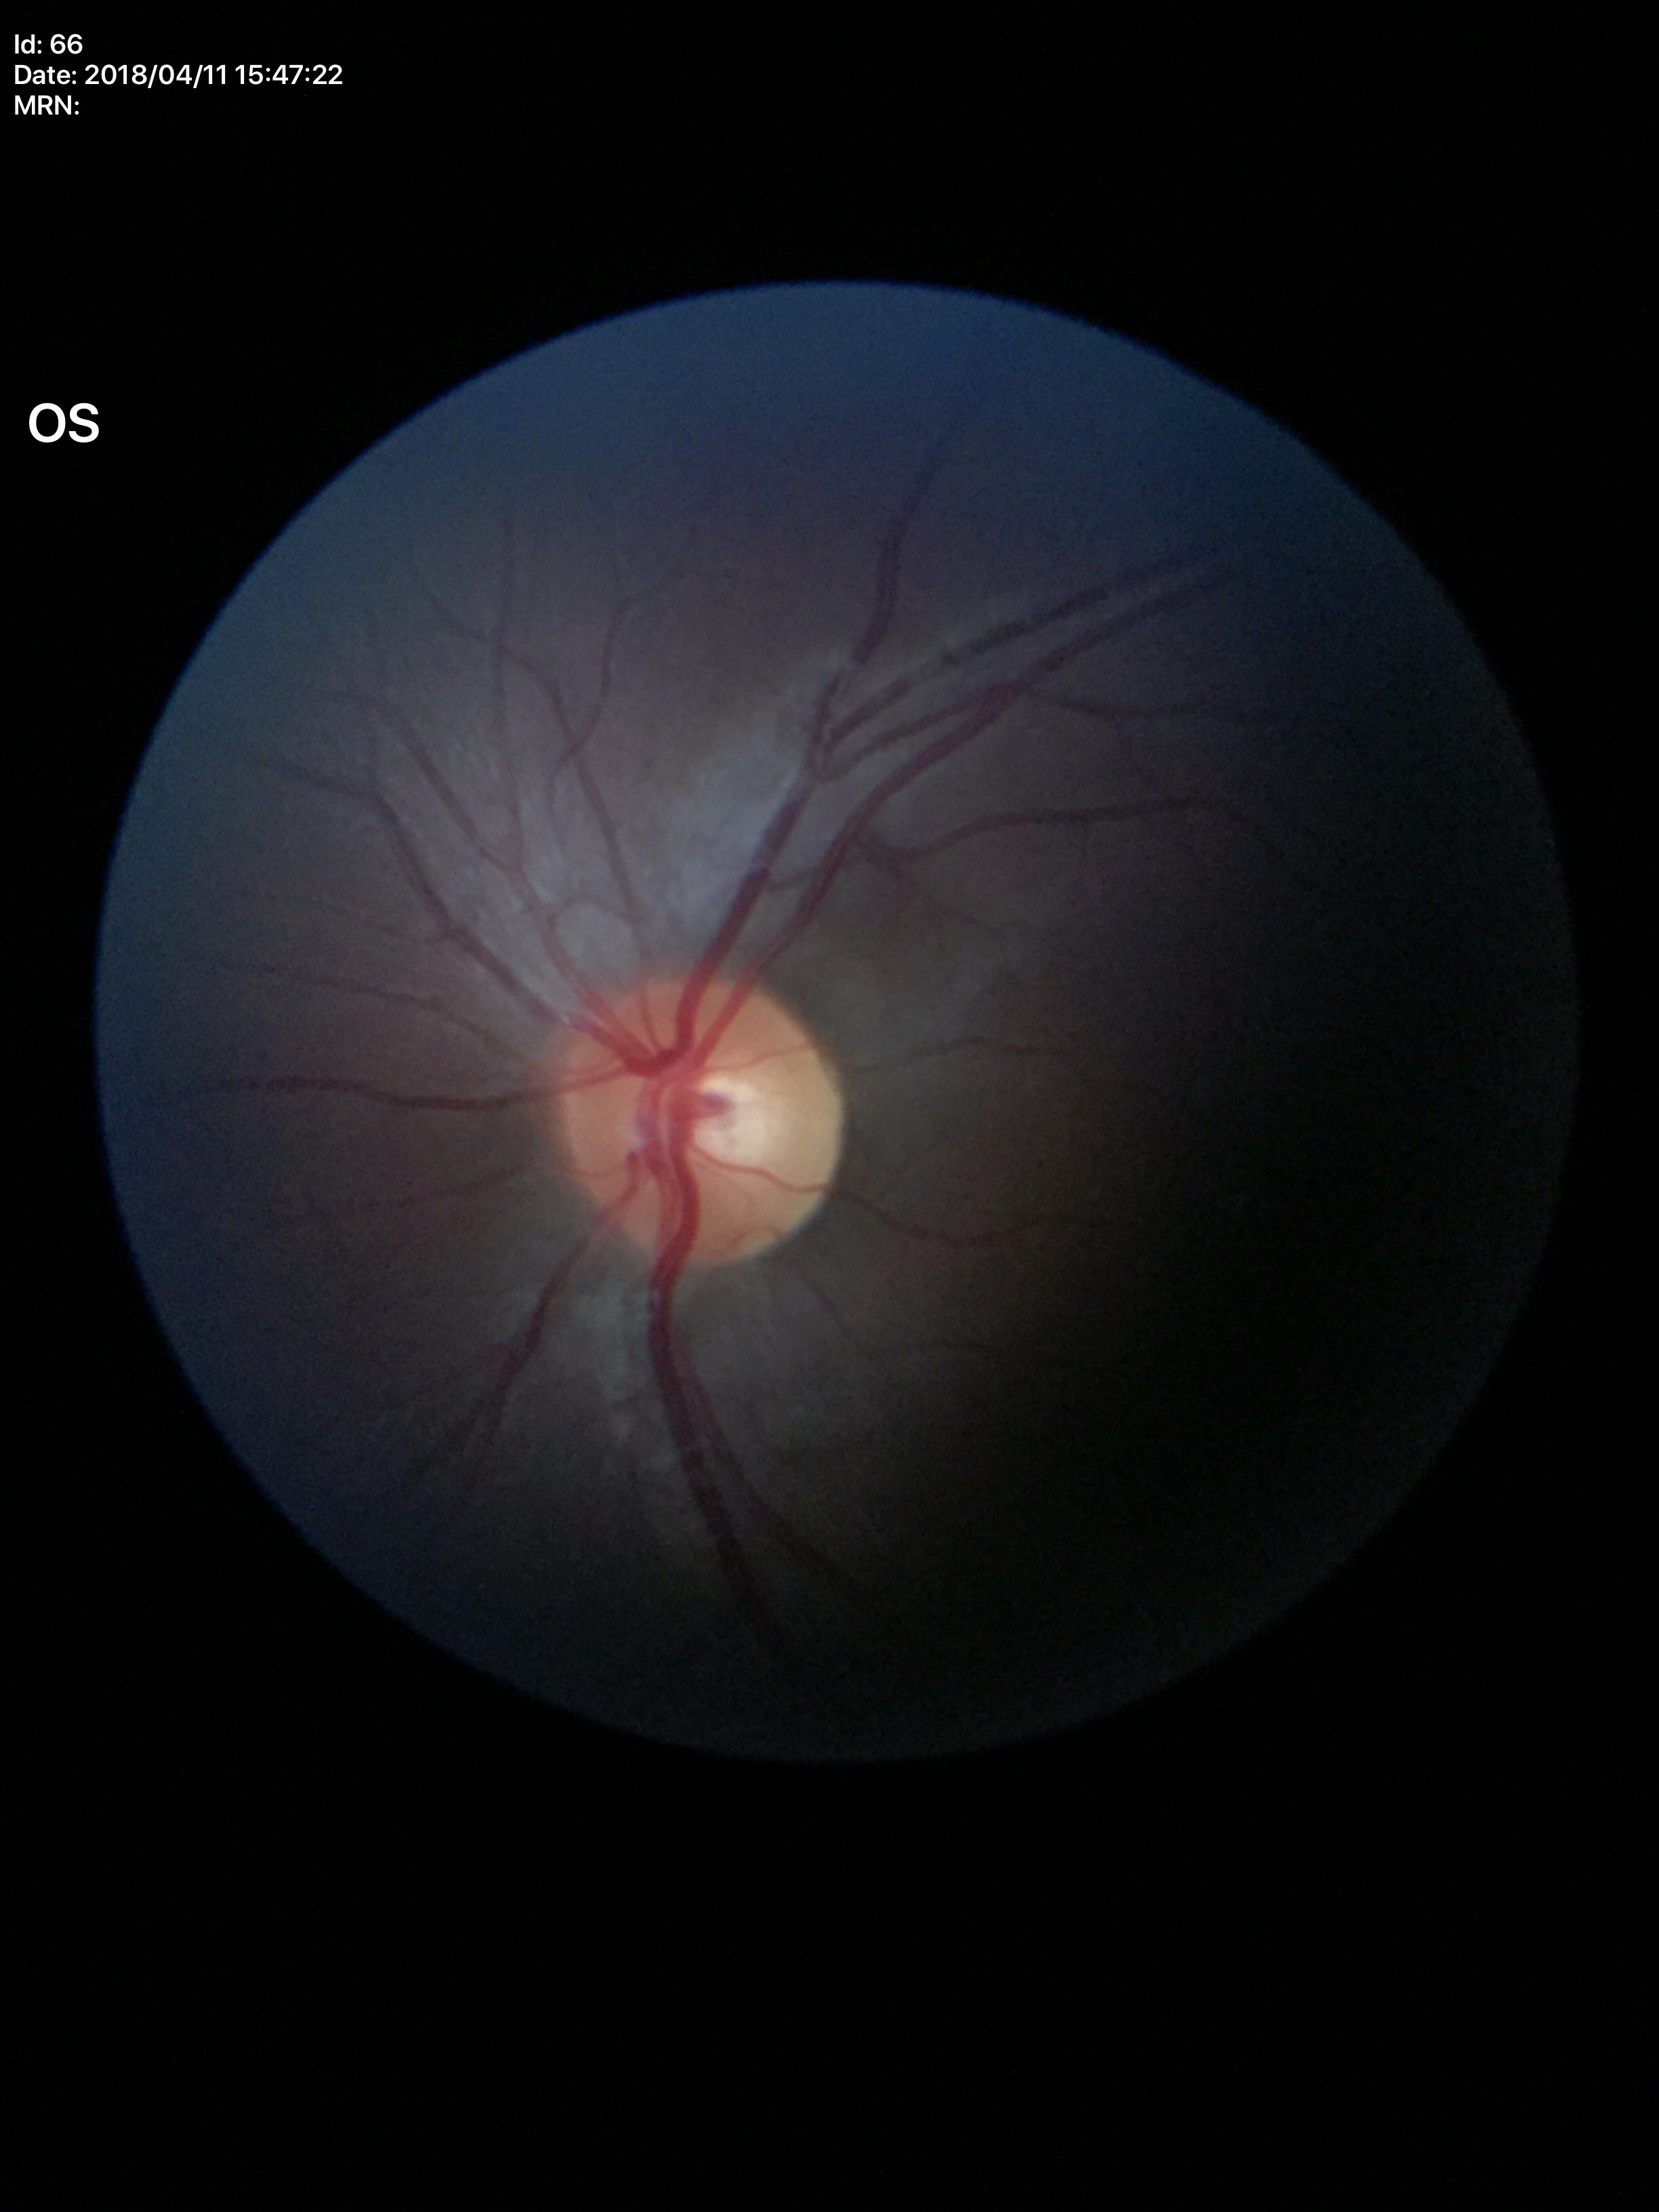

vertical CDR (VCDR)=0.46 | horizontal cup-disc ratio (HCDR)=0.49 | Glaucoma impression=not suspect